Macula-centered: 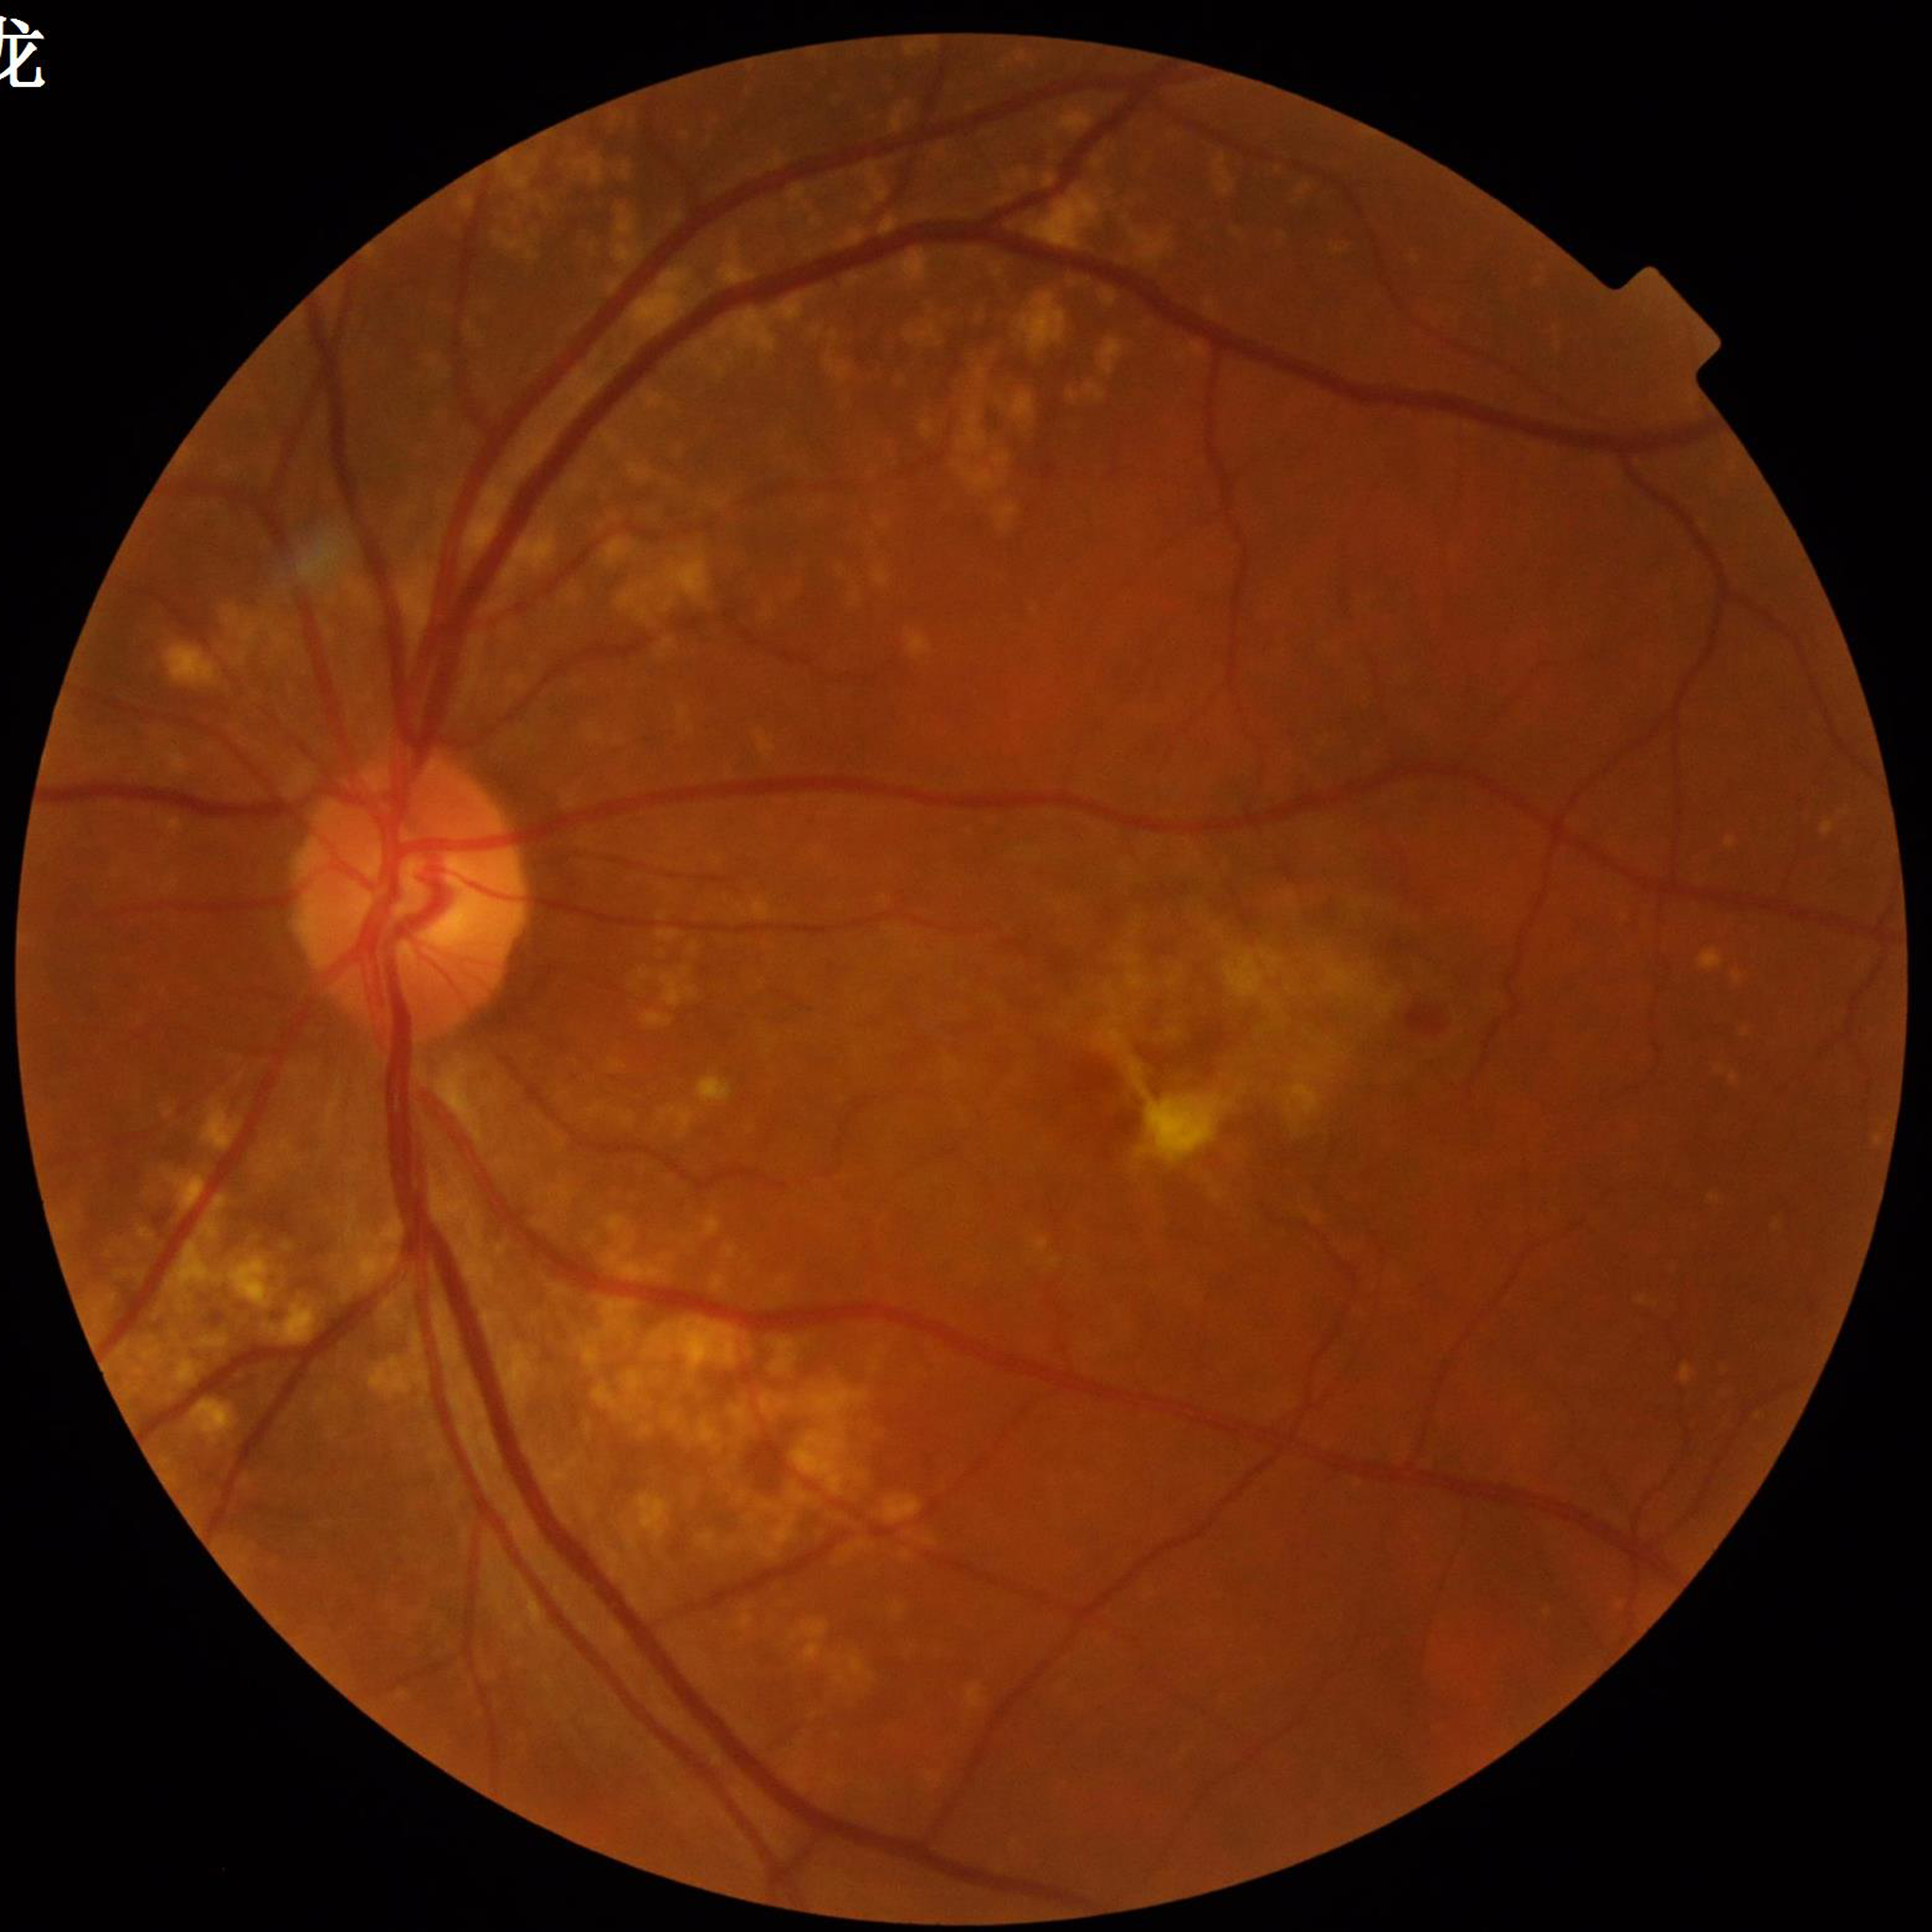 Quality: no quality issues identified. This fundus photograph is from a patient diagnosed with AMD.